Color fundus image, 45-degree field of view:
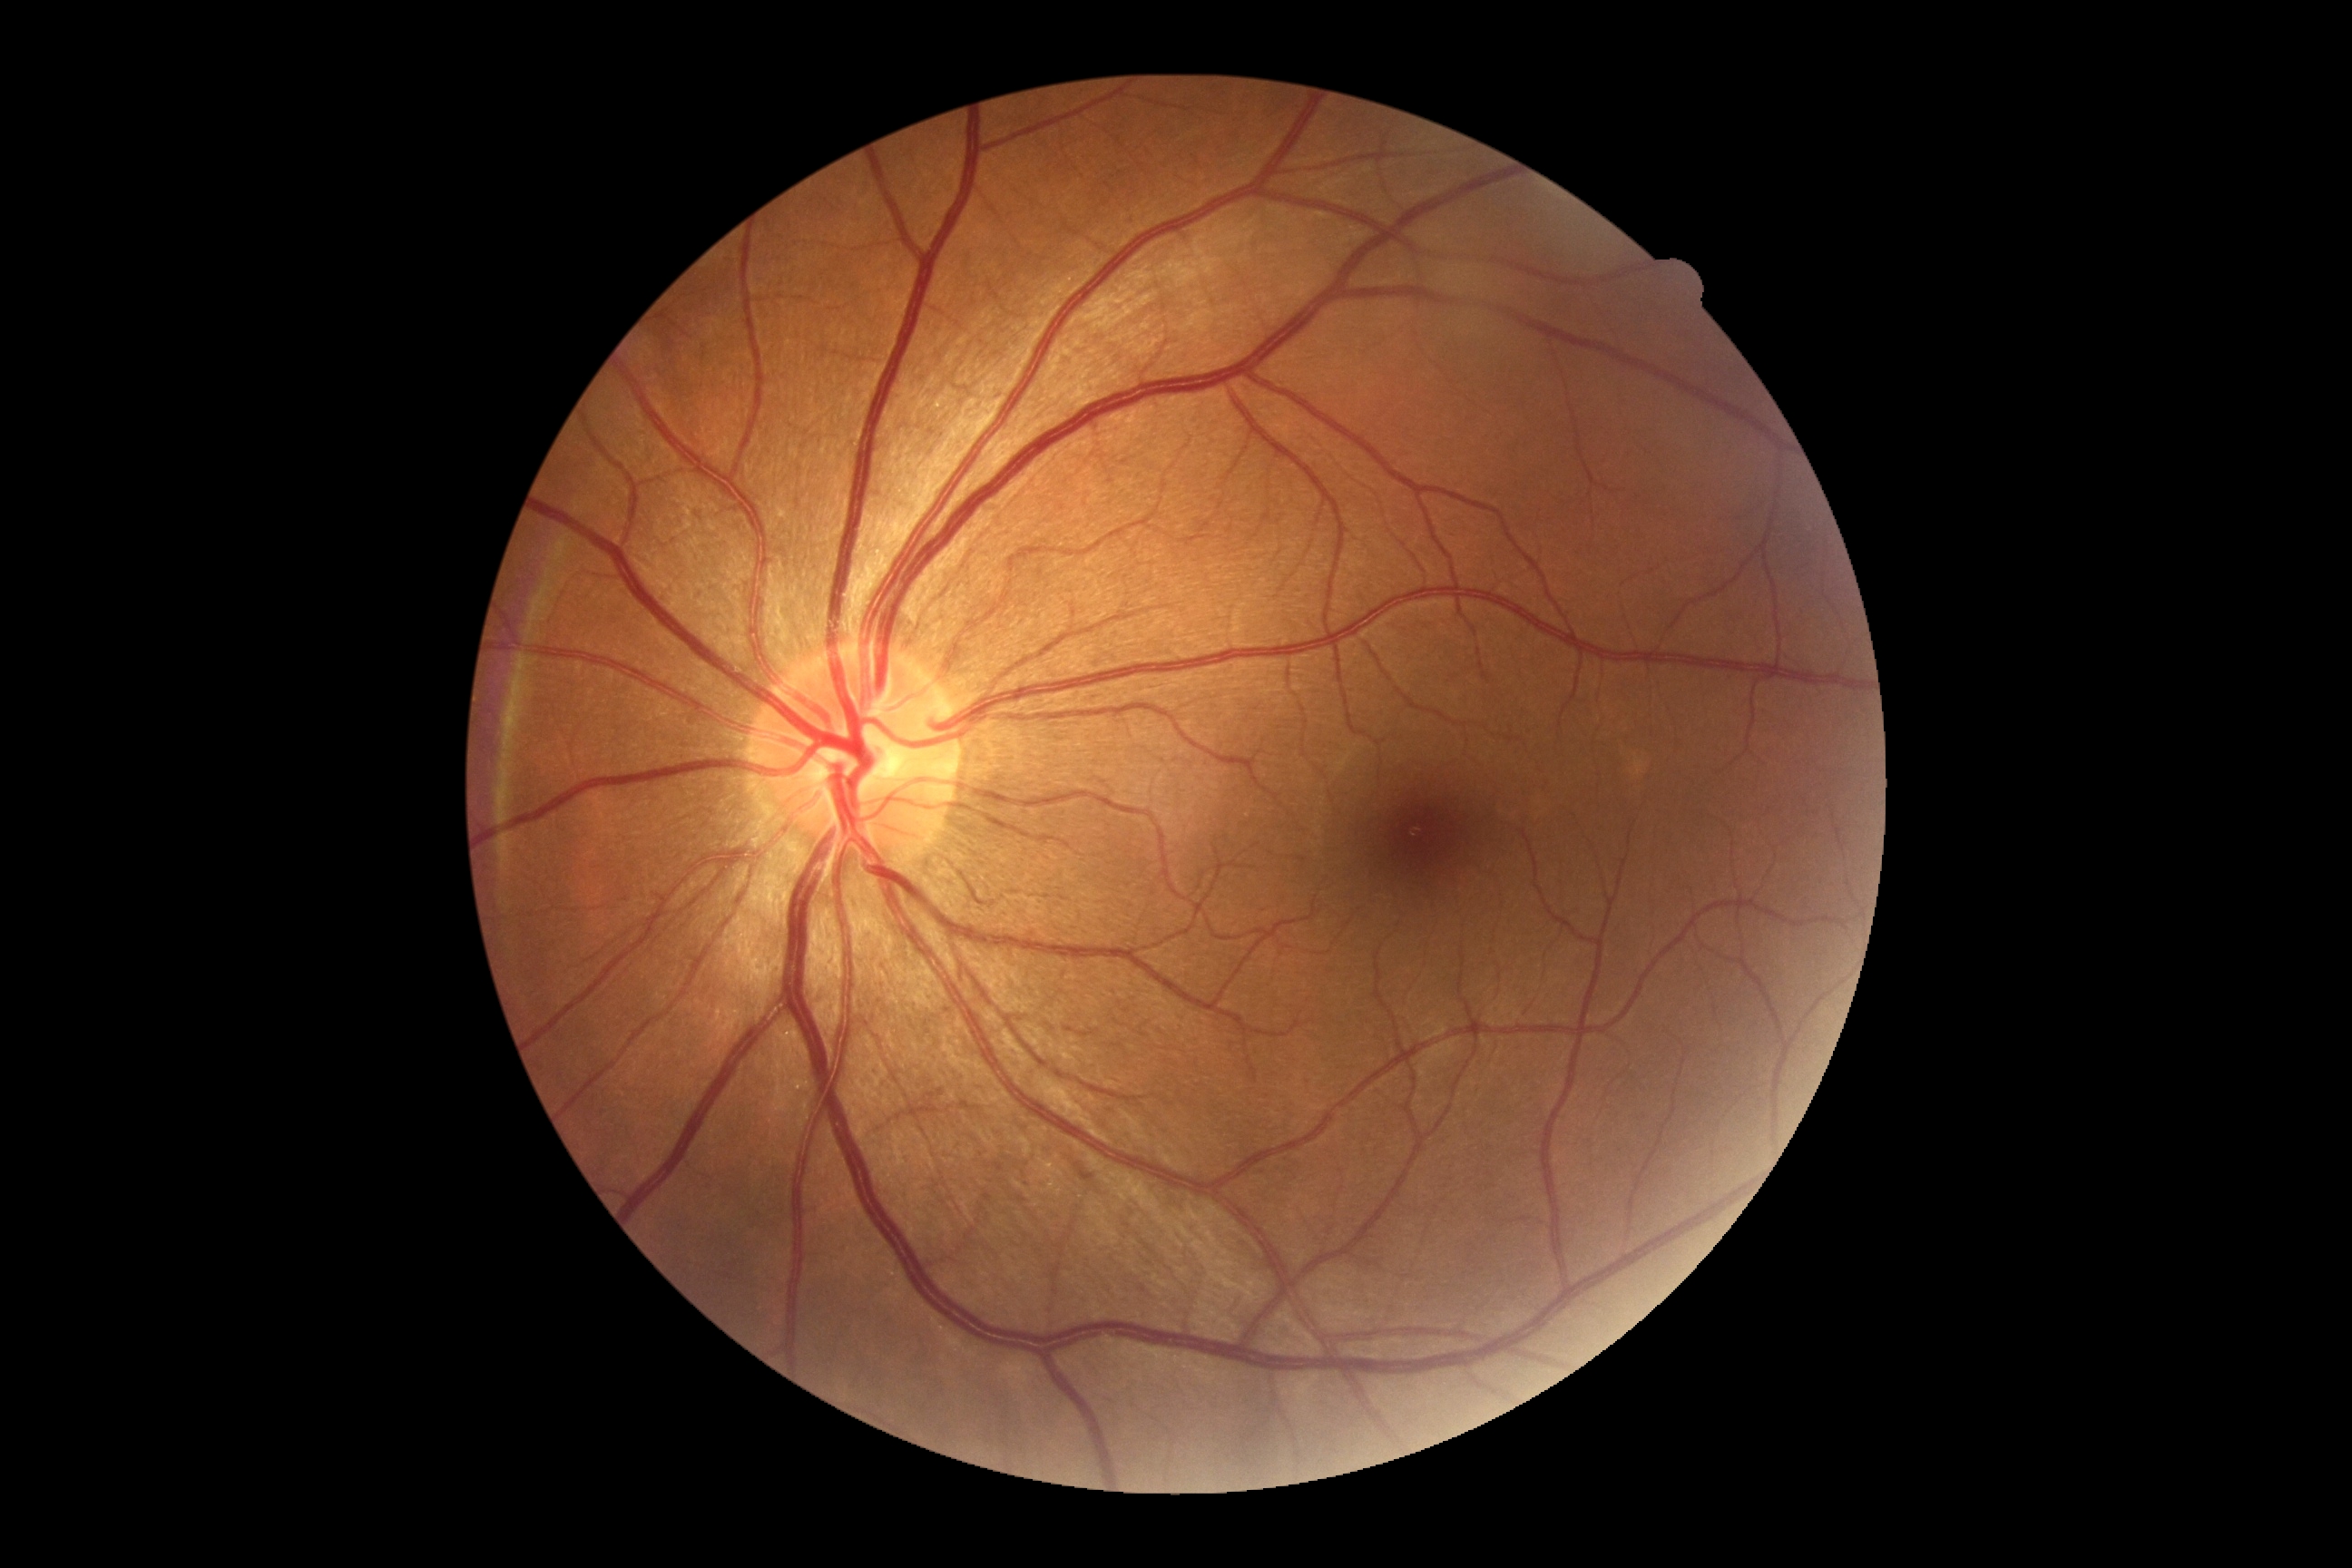
DR impression: no signs of DR; diabetic retinopathy: grade 0 (no apparent retinopathy).